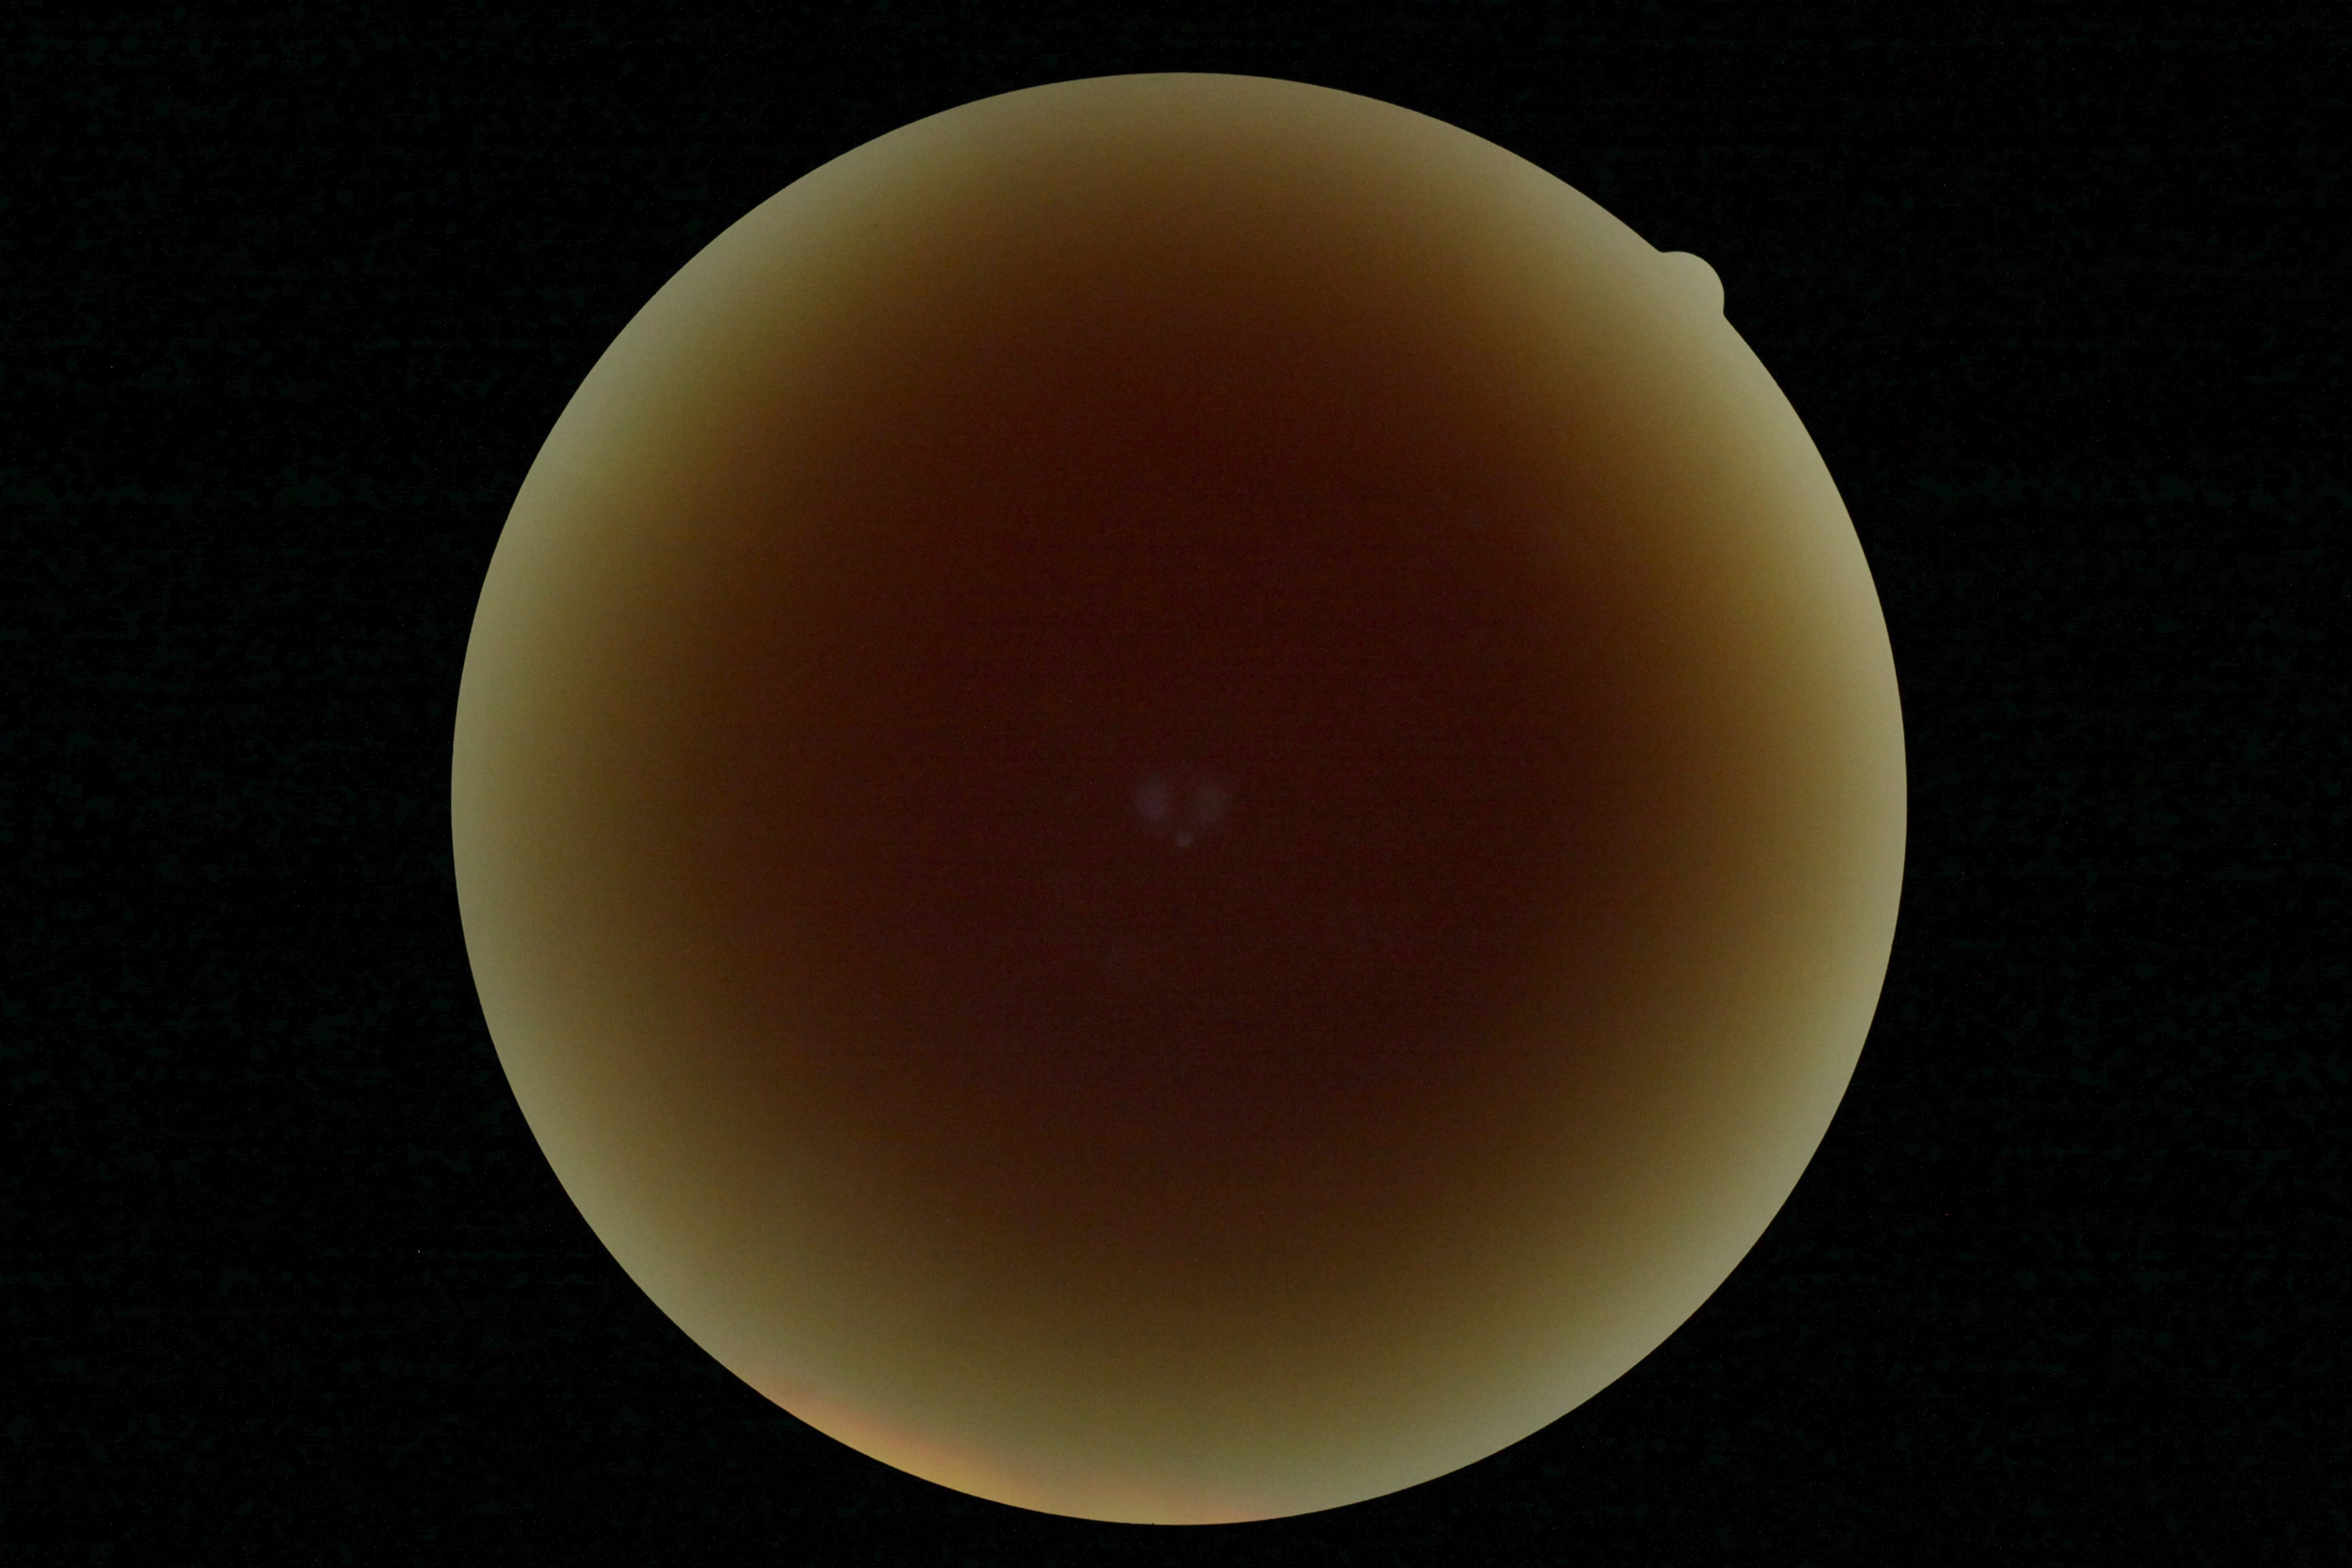 diabetic retinopathy grade: ungradable.